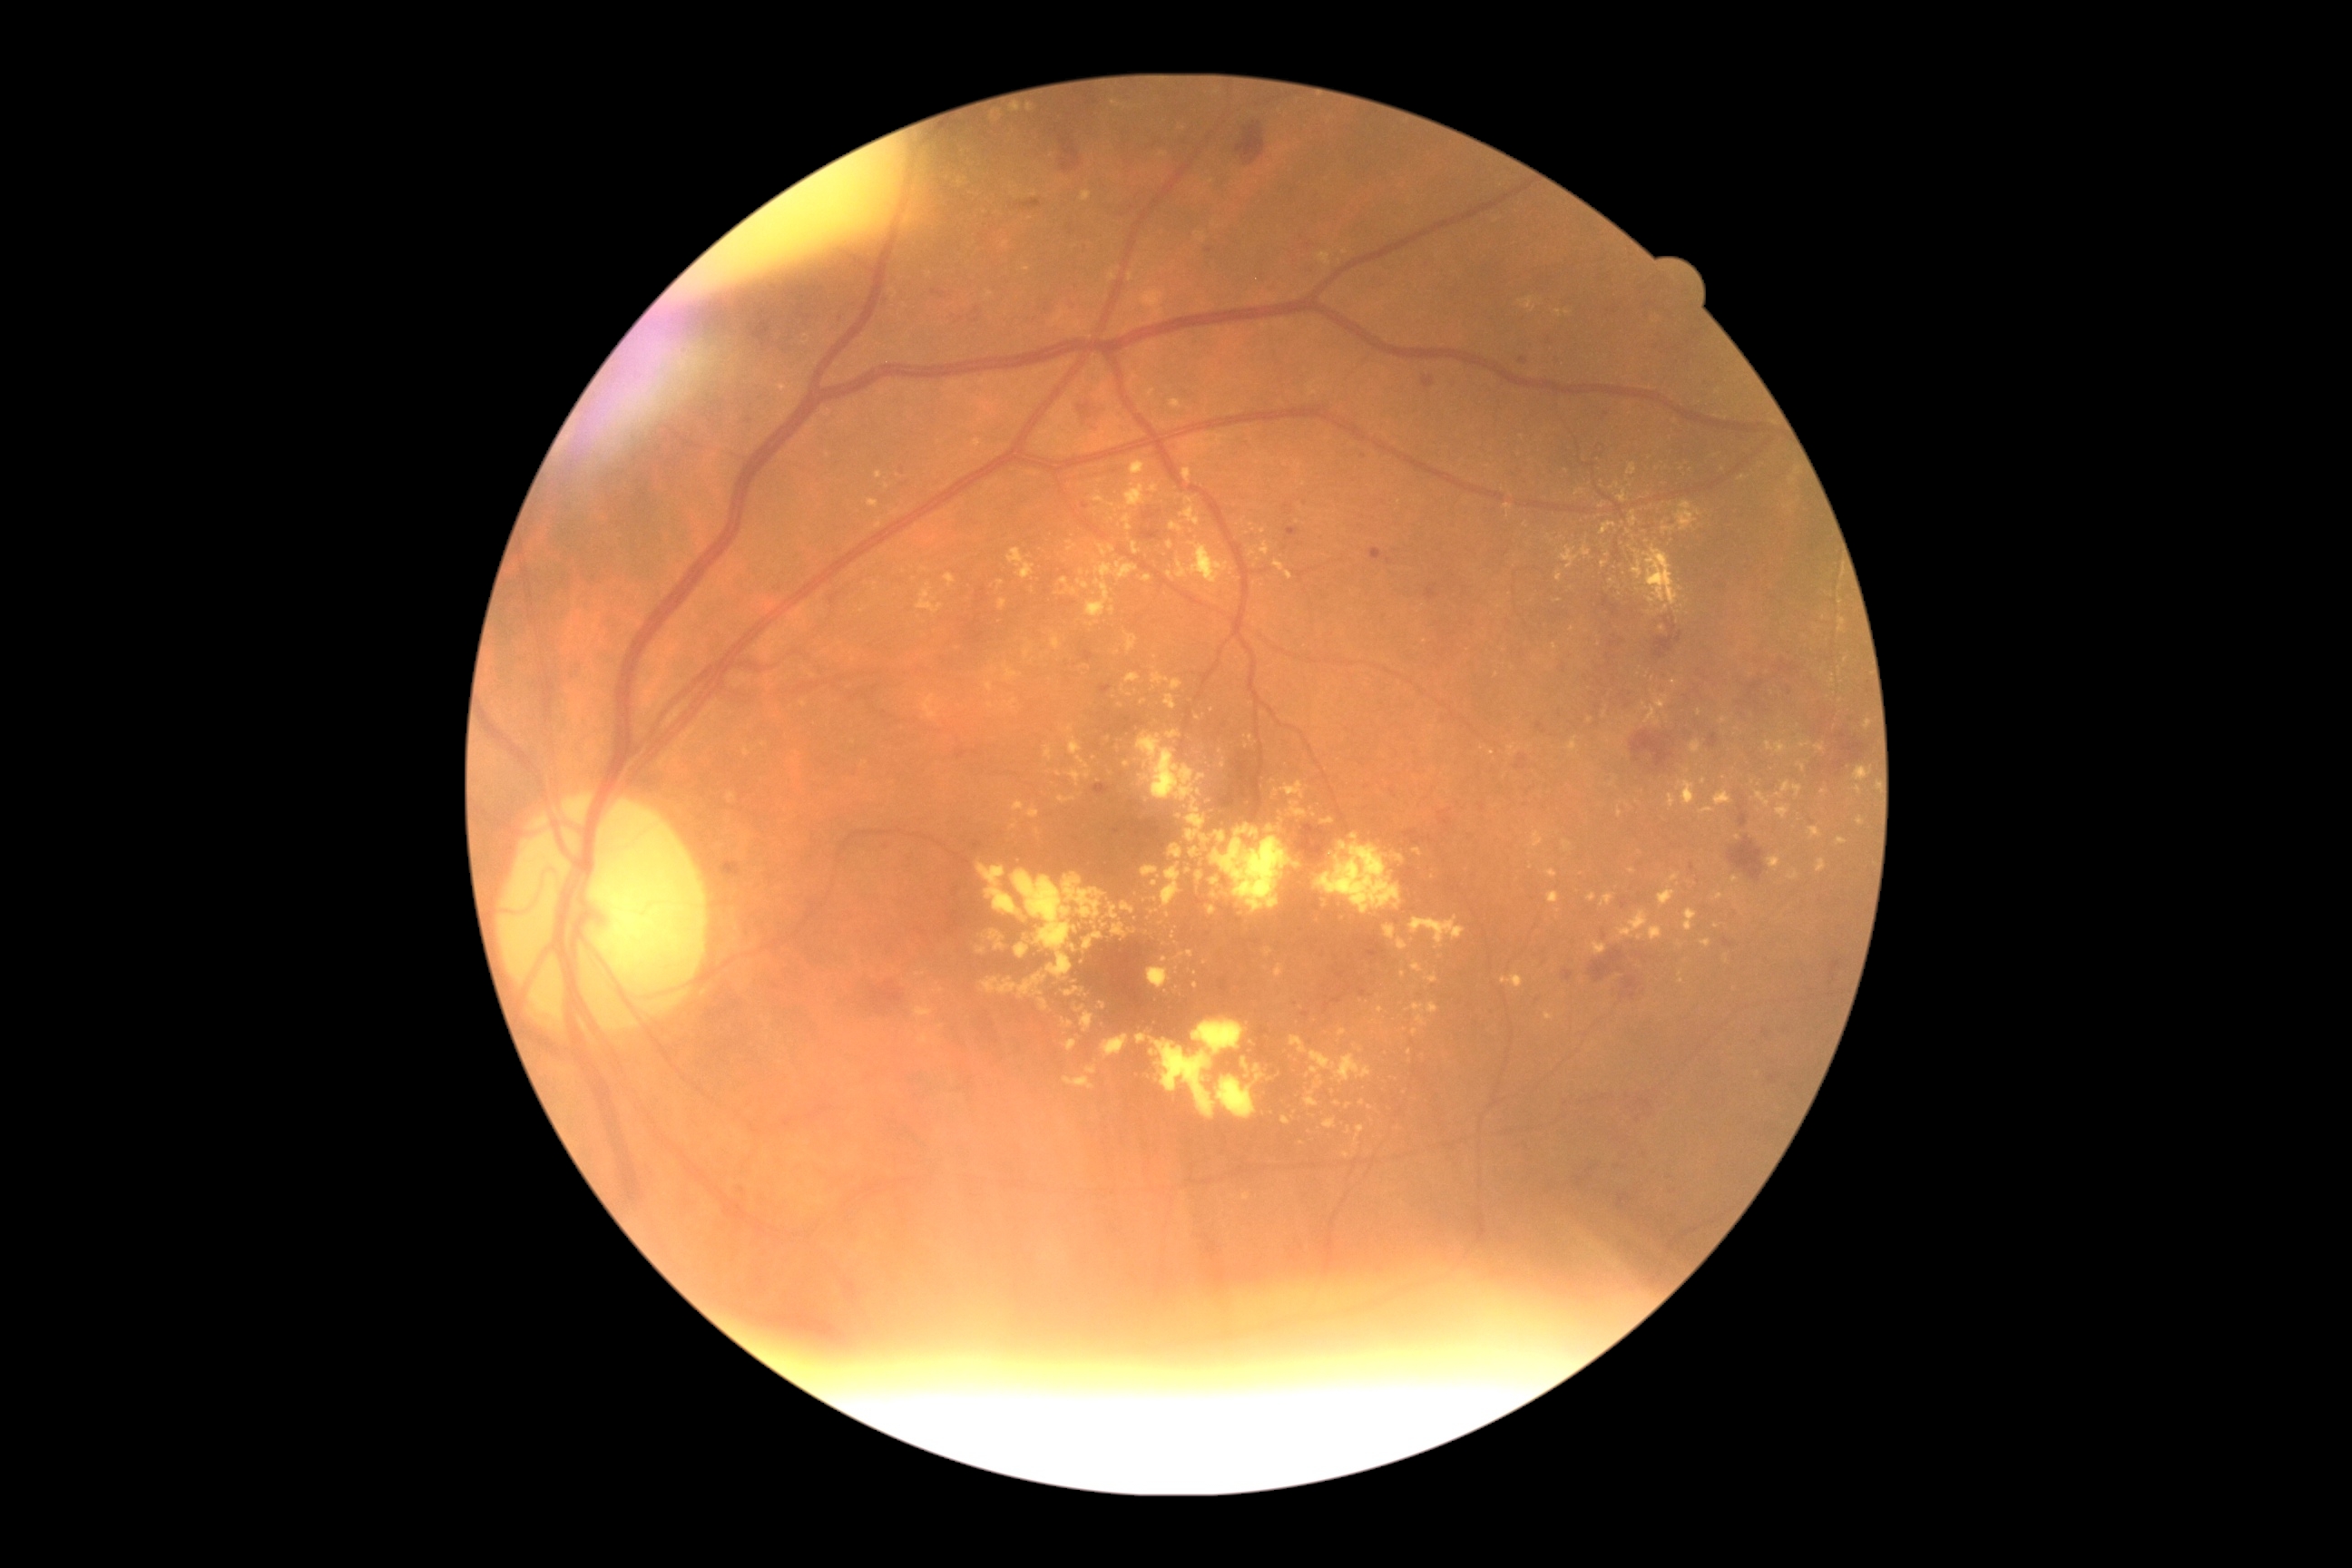

Diabetic retinopathy (DR) is 2; non-proliferative diabetic retinopathy
Representative lesions:
hard exudates (EXs) (partial): (left=1618, top=491, right=1627, bottom=504), (left=1661, top=524, right=1676, bottom=534), (left=1282, top=1117, right=1291, bottom=1124), (left=917, top=583, right=943, bottom=614), (left=1533, top=832, right=1544, bottom=848), (left=1317, top=834, right=1402, bottom=916), (left=1075, top=1006, right=1086, bottom=1014), (left=1620, top=562, right=1627, bottom=574), (left=988, top=932, right=1006, bottom=950), (left=1355, top=1126, right=1366, bottom=1148), (left=1126, top=674, right=1141, bottom=683)
Small EXs approximately at [1026,269], [1298,522], [1790,506], [1652,599], [1127,765], [1363,1103], [865,763], [1001,583]
hemorrhages (HEs) (partial): (left=1618, top=1193, right=1631, bottom=1208), (left=1015, top=199, right=1043, bottom=211), (left=1629, top=992, right=1636, bottom=1001), (left=1422, top=377, right=1435, bottom=389), (left=1723, top=939, right=1734, bottom=948), (left=1589, top=948, right=1627, bottom=985), (left=1295, top=825, right=1335, bottom=867), (left=1072, top=400, right=1097, bottom=422), (left=1440, top=819, right=1451, bottom=827), (left=1740, top=805, right=1750, bottom=828), (left=870, top=983, right=905, bottom=1015), (left=970, top=614, right=985, bottom=645)
Small HEs approximately at [1122,776], [887,846], [1541,1255], [1744,799]